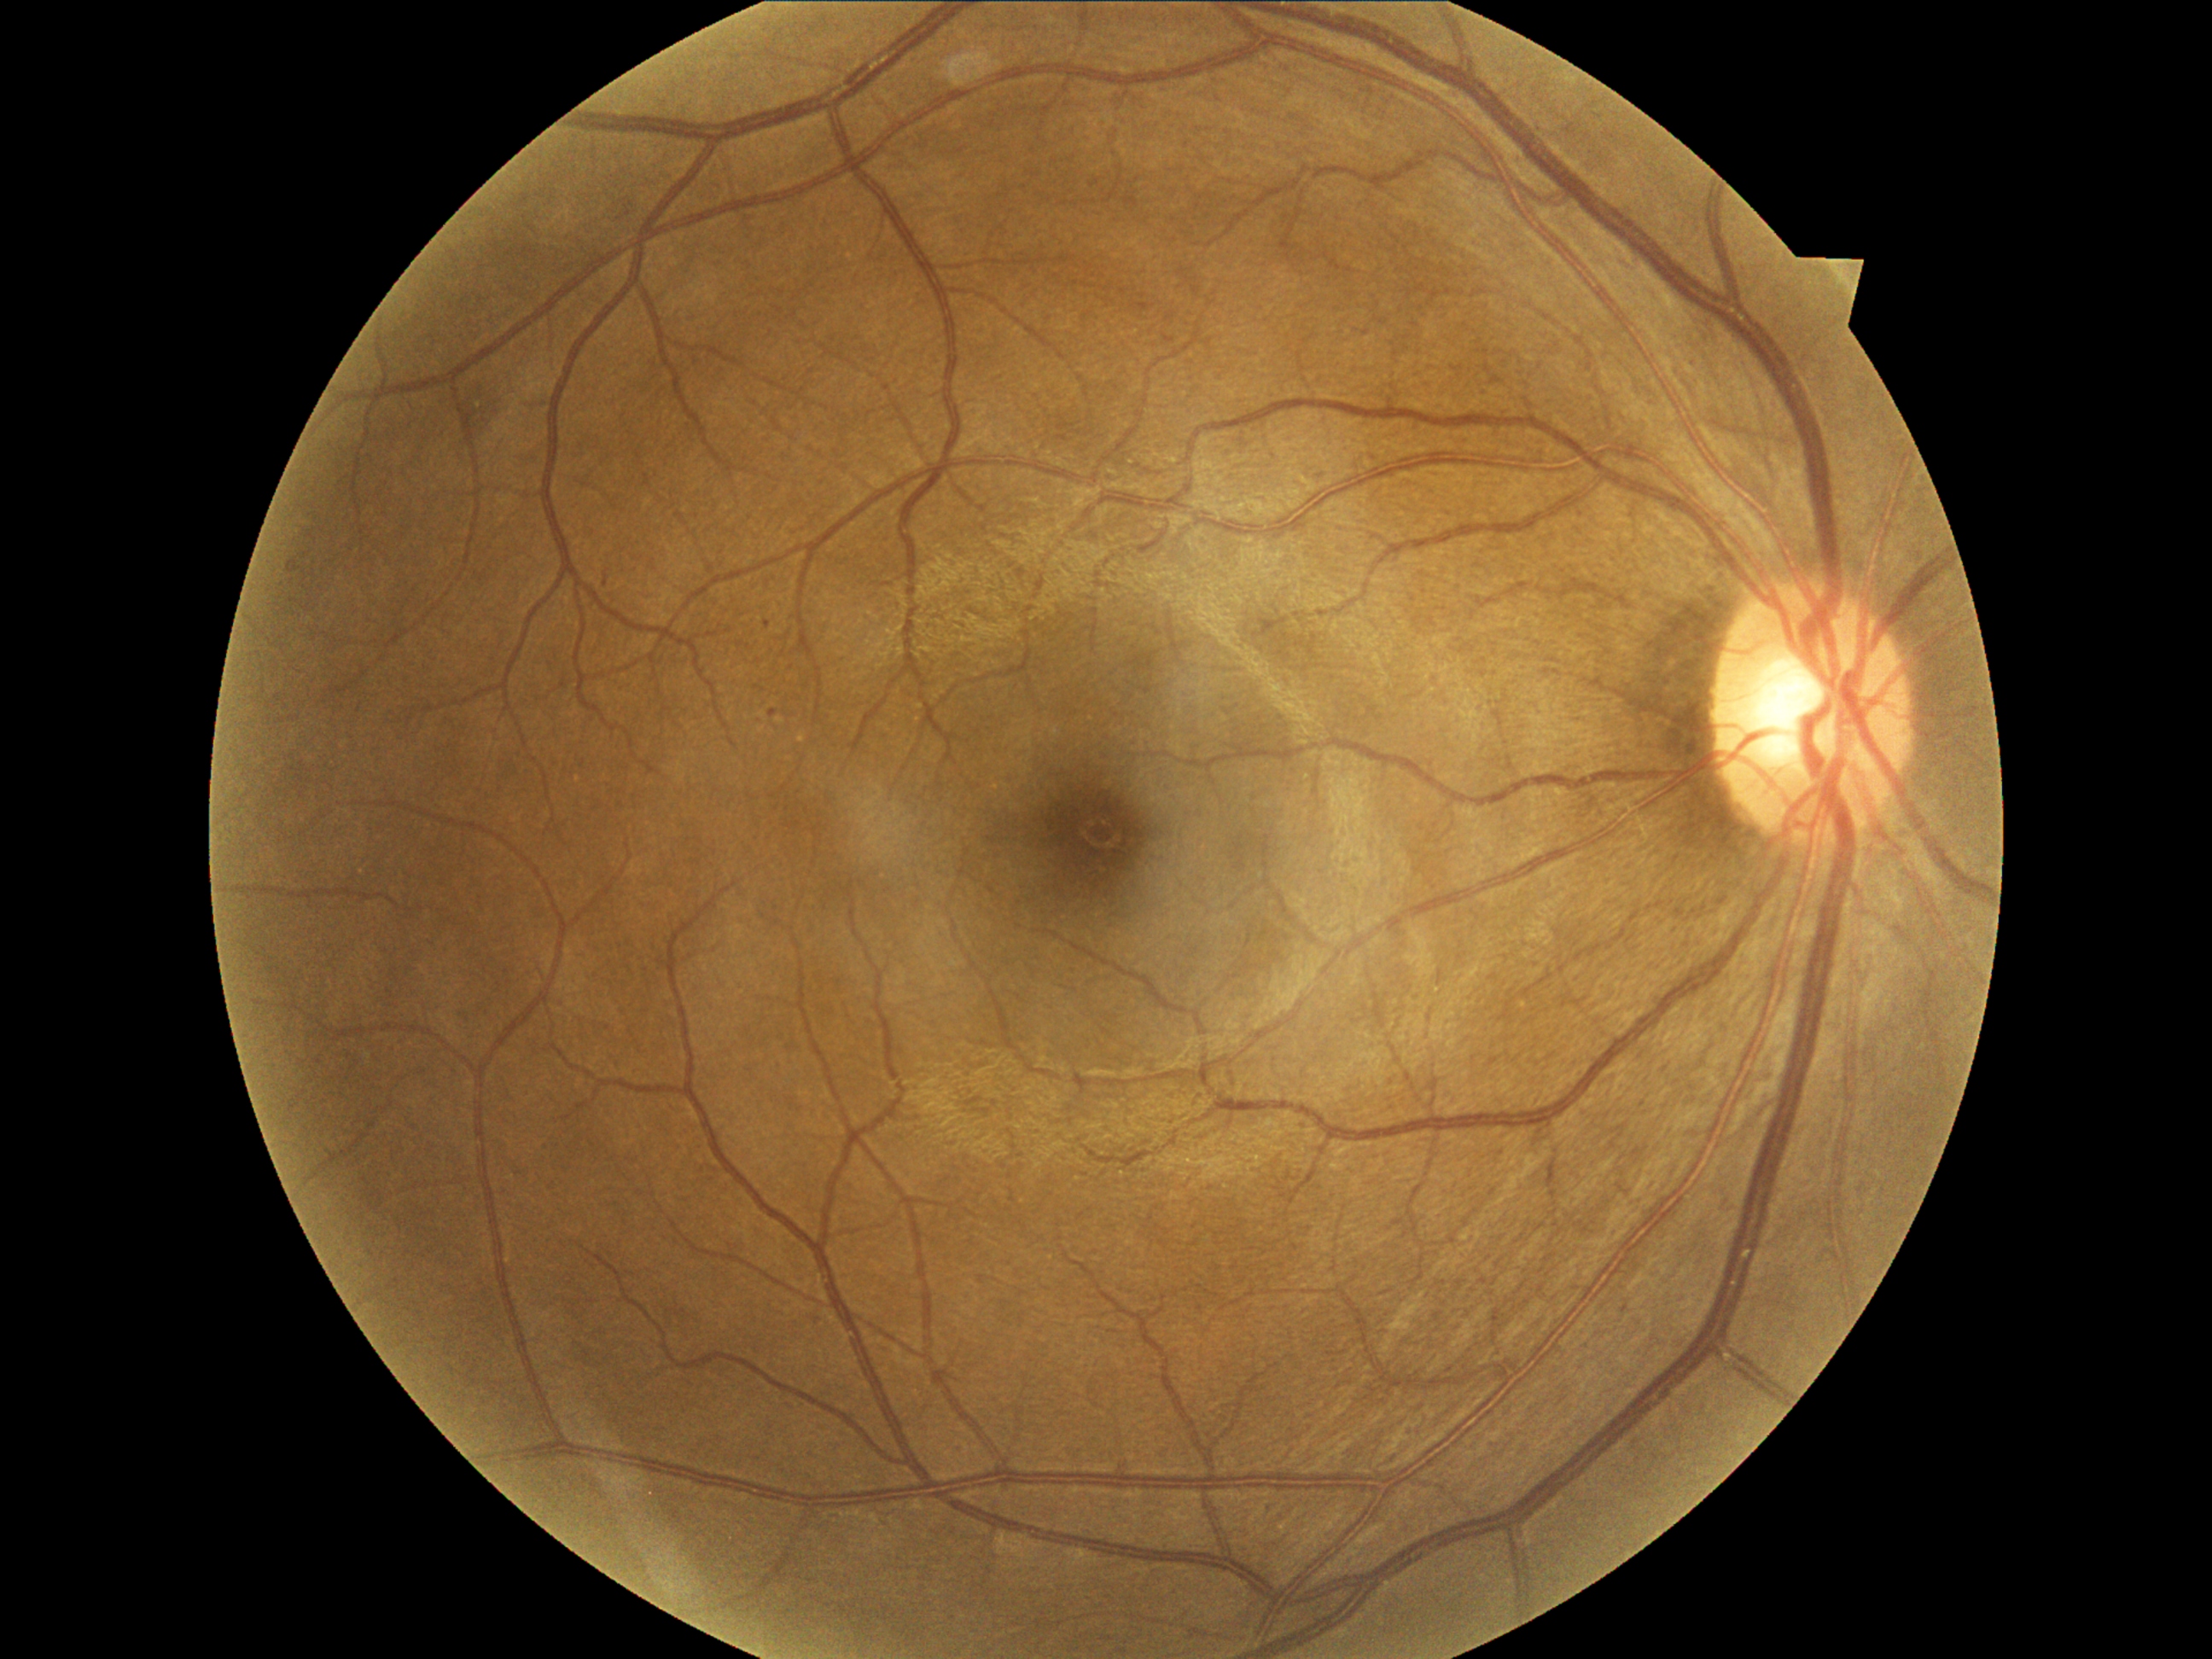 DR class=non-proliferative diabetic retinopathy, diabetic retinopathy grade=mild non-proliferative diabetic retinopathy (1).